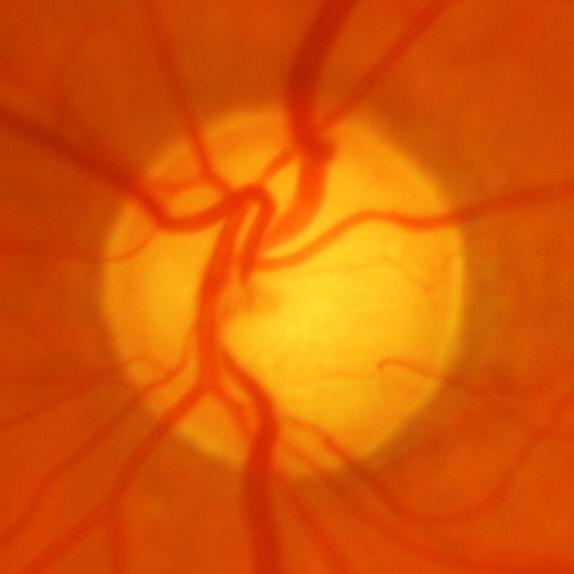

Optic disc photograph showing glaucomatous findings.